Fundus photo. Image size 1380x1382. 45-degree field of view — 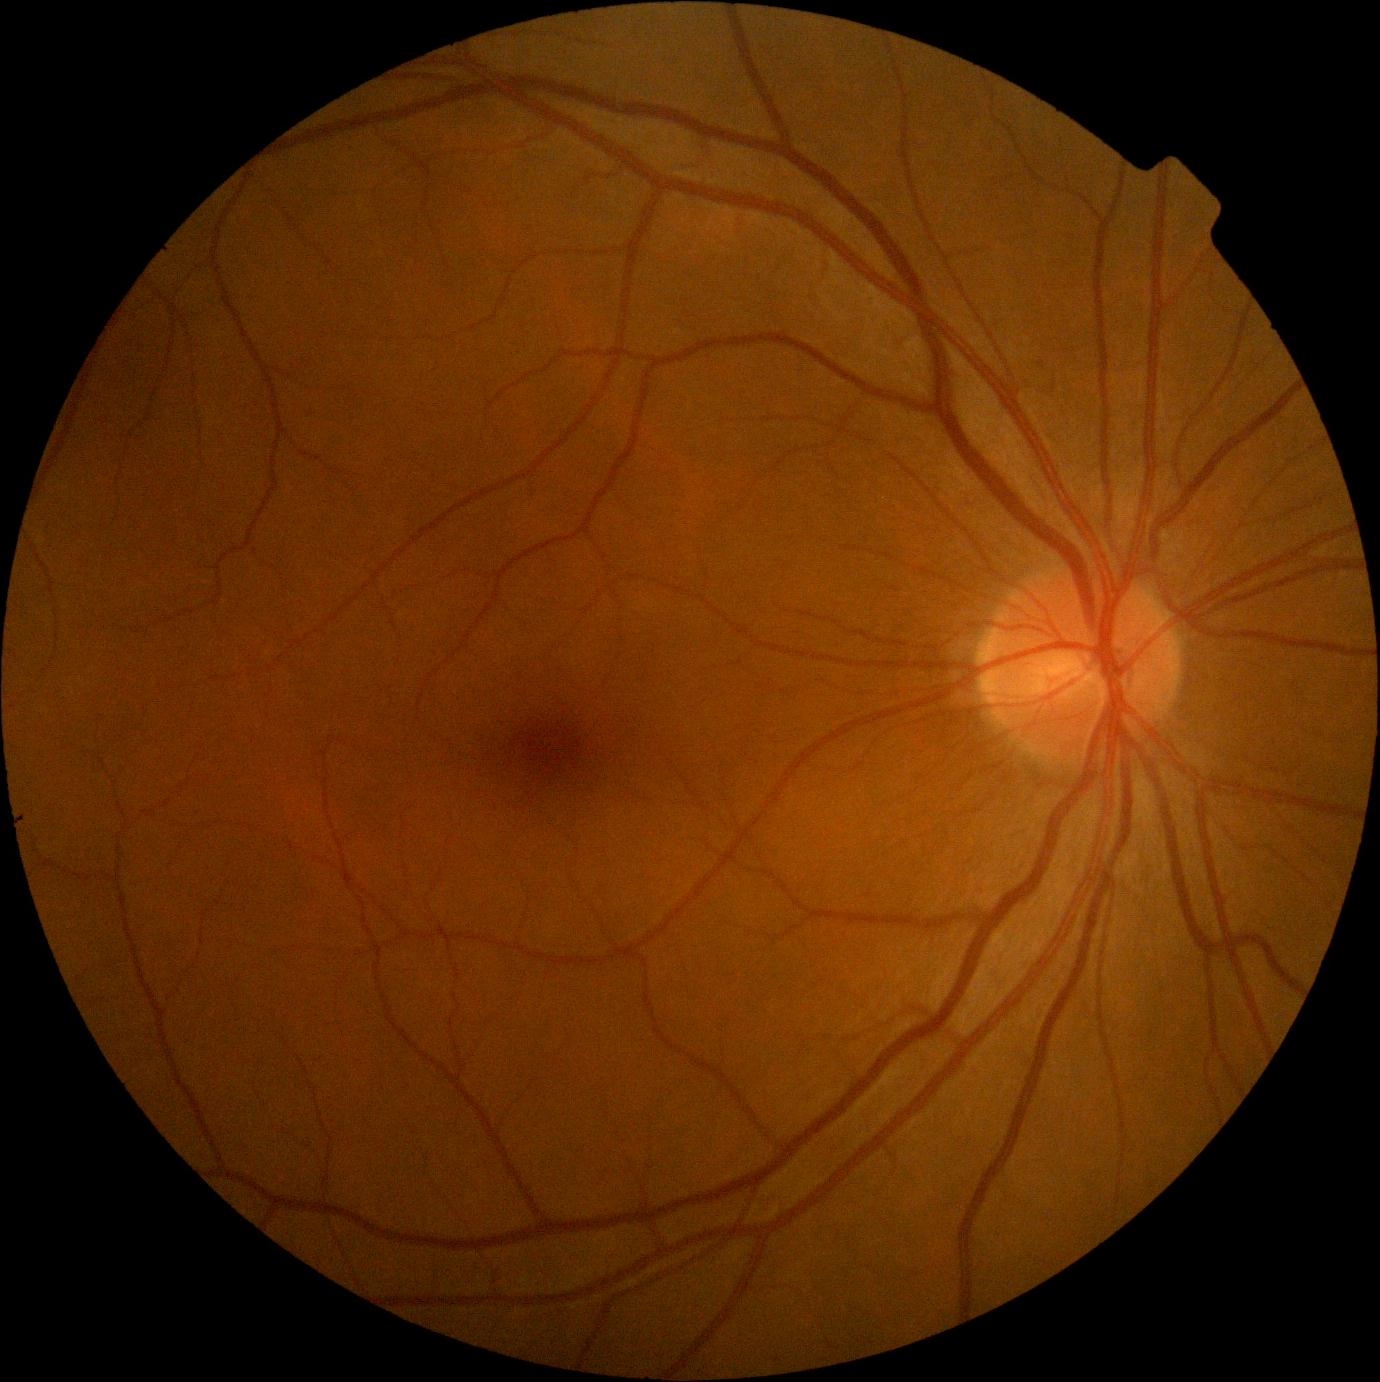 * DR impression: no signs of DR
* diabetic retinopathy: no apparent diabetic retinopathy (grade 0)